CFP · 2352x1568px:
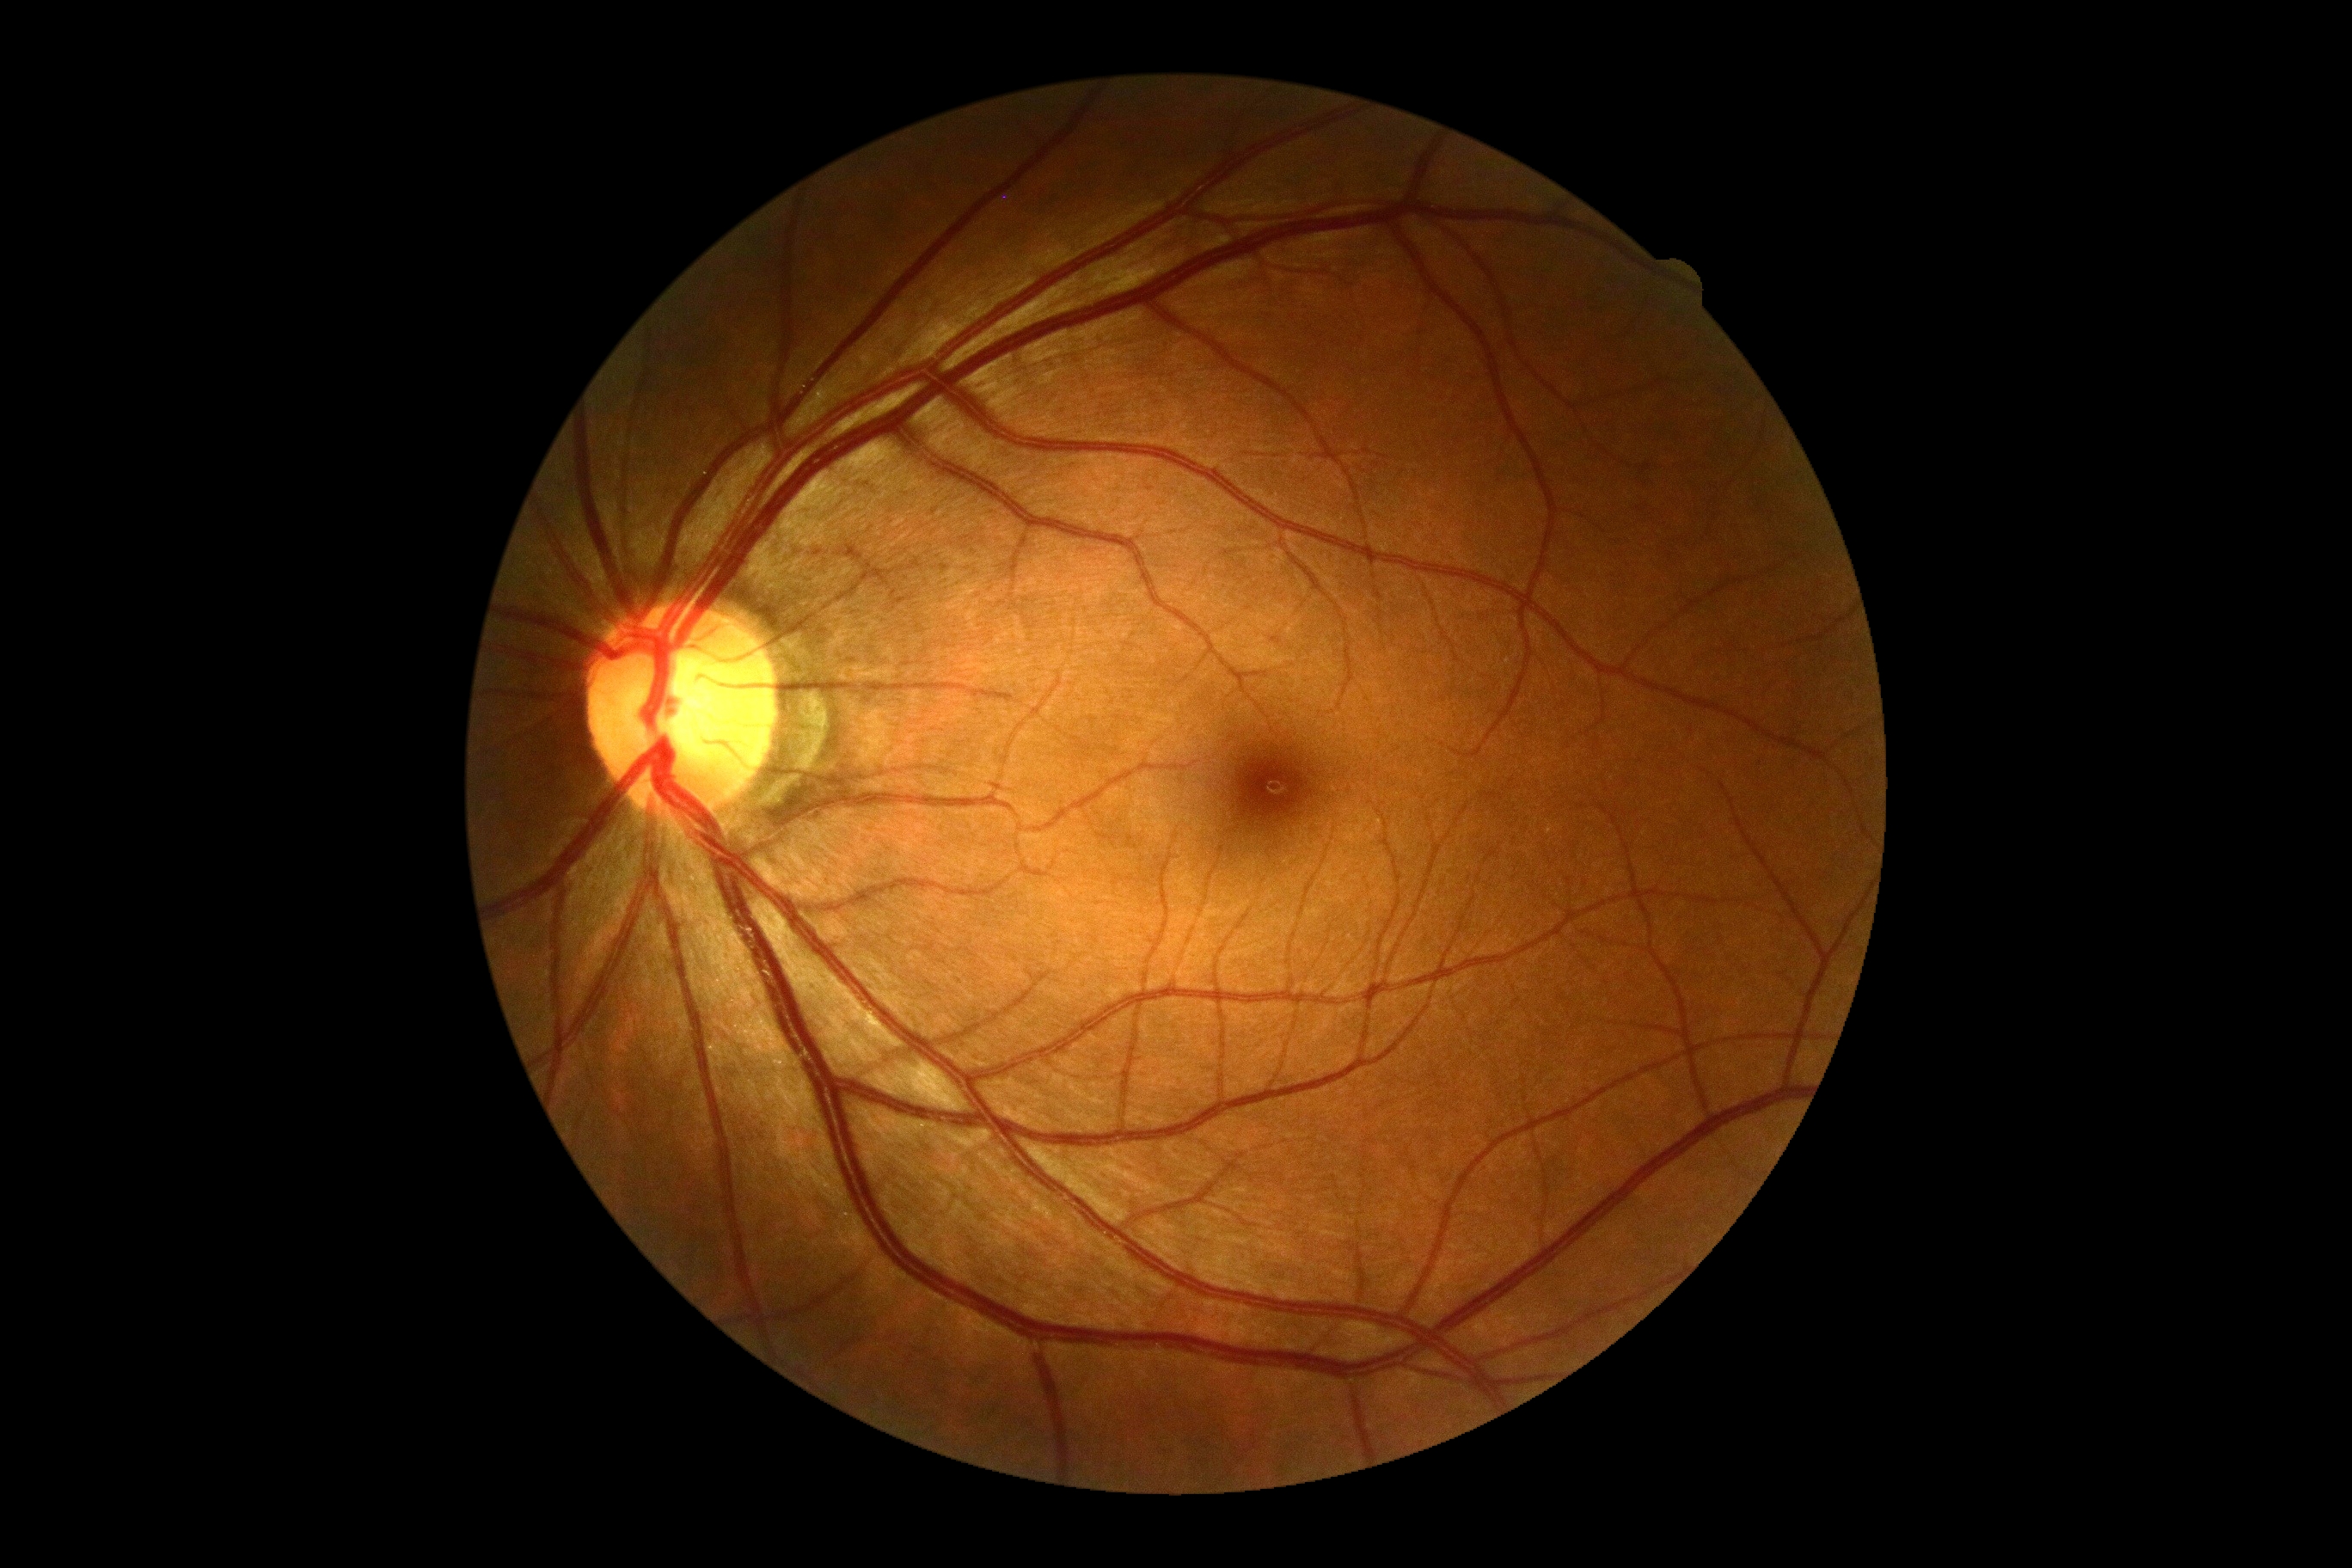

DR is 0.
No signs of diabetic retinopathy.